Infant wide-field retinal image: 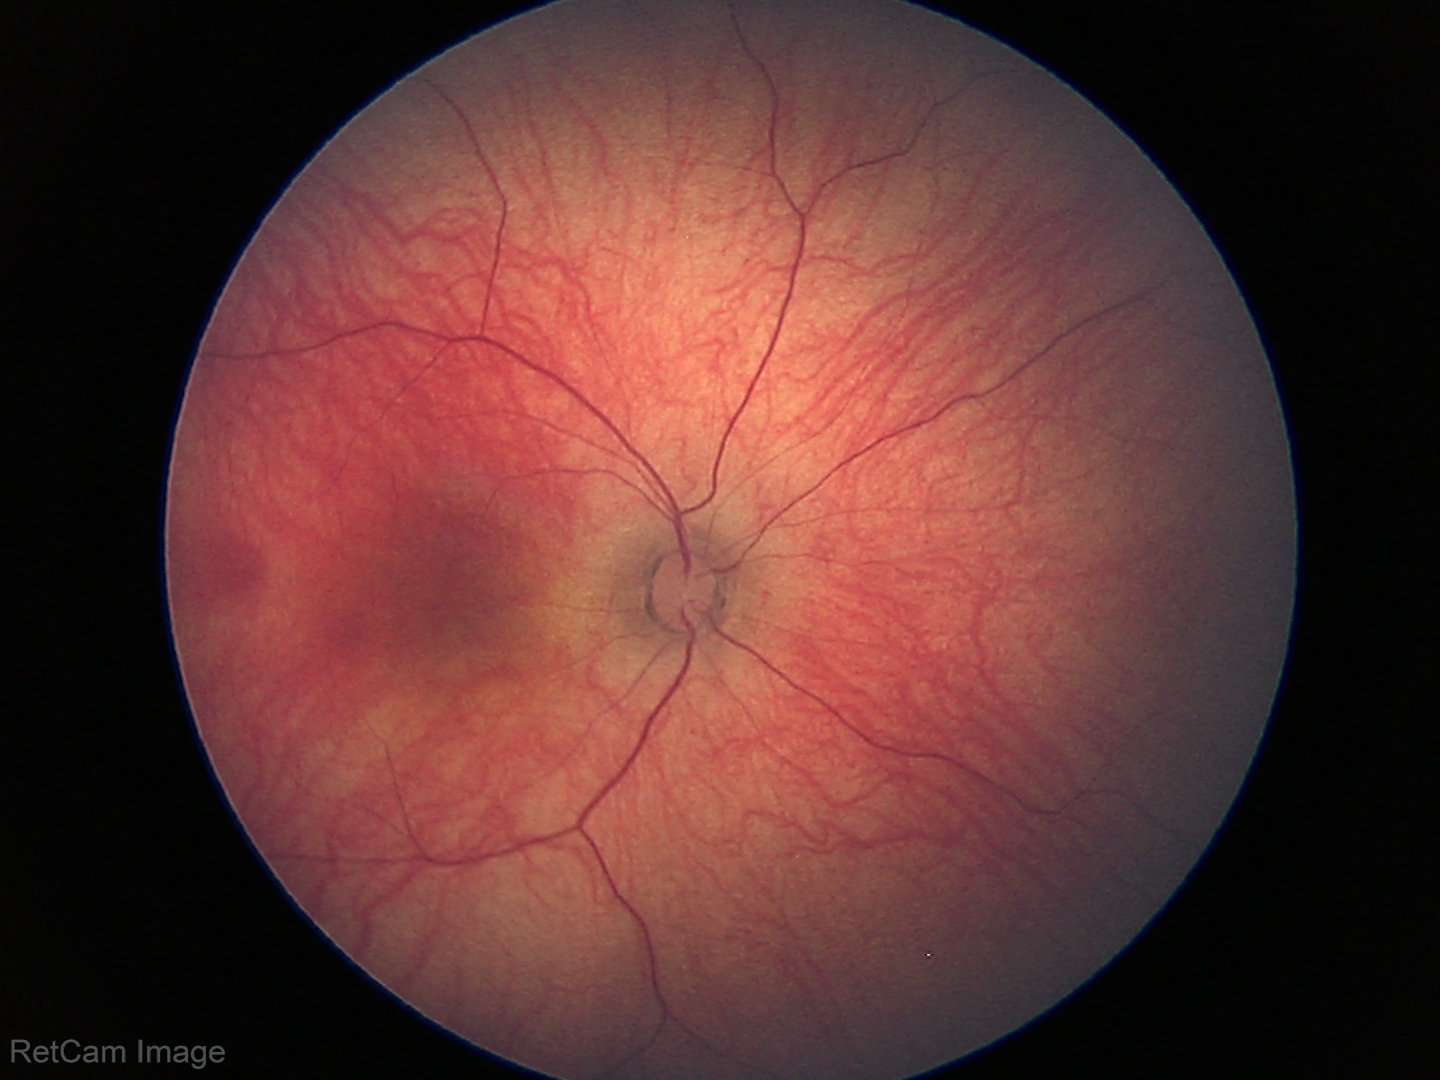 Impression: physiological.